Nonmydriatic. 45° field of view.
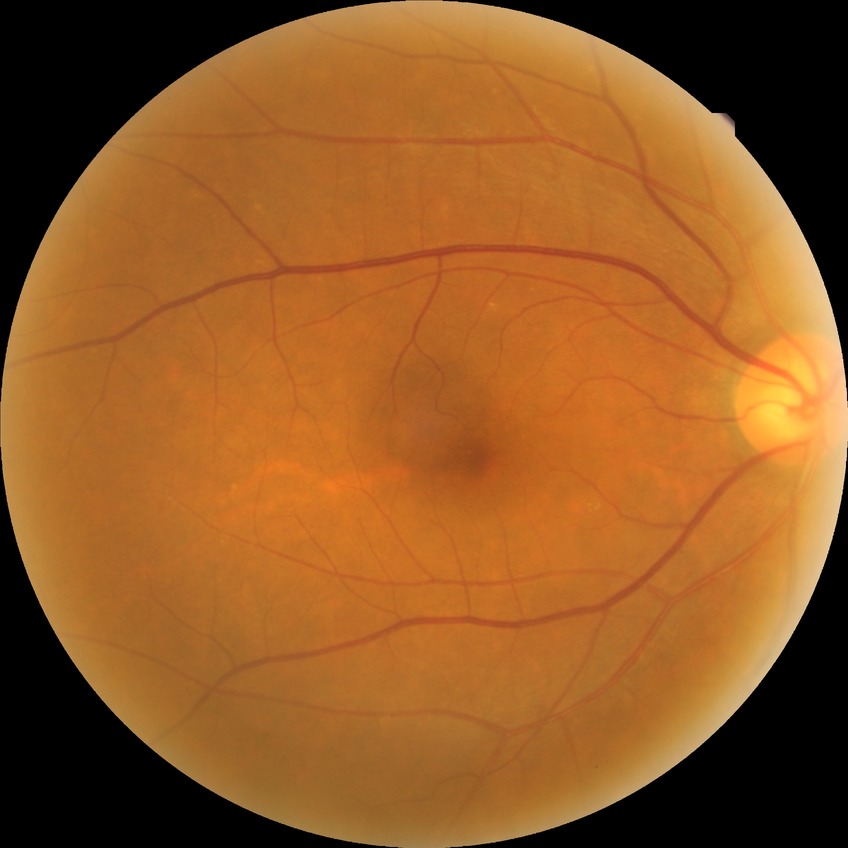

Davis grading is no diabetic retinopathy.